130° field of view (Clarity RetCam 3) · image size 640x480 · wide-field fundus photograph of an infant
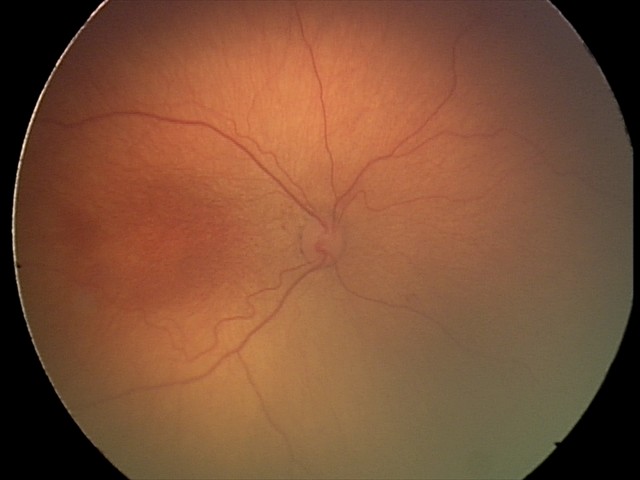 Screening examination consistent with ROP stage 2.